No pharmacologic dilation; 45-degree field of view; color fundus image:
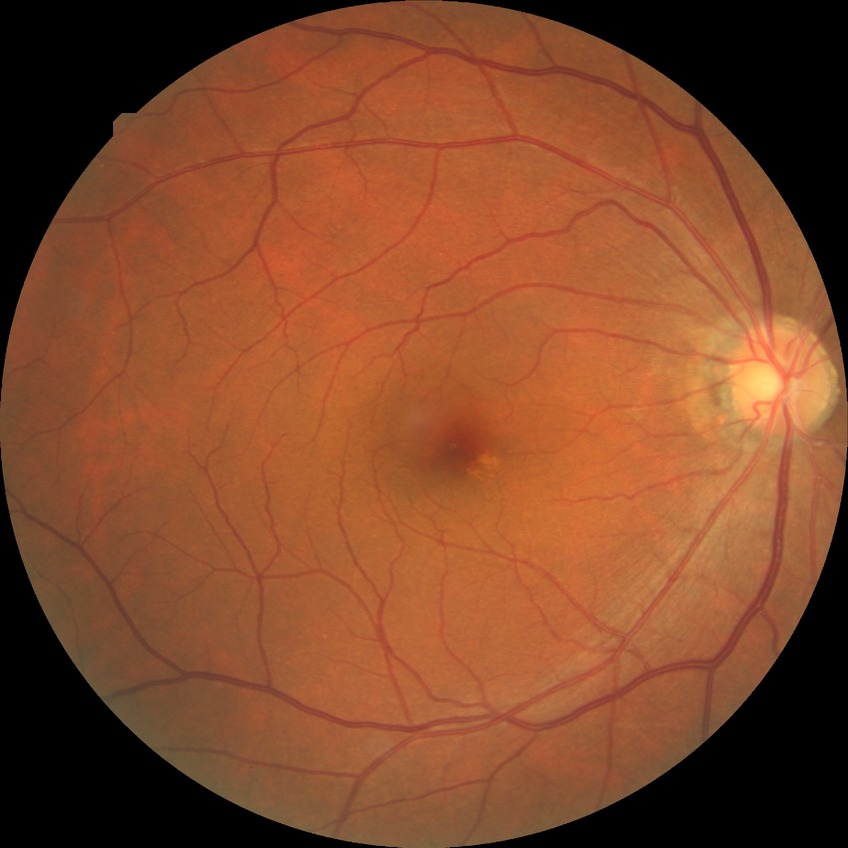

– diabetic retinopathy (DR) — NDR (no diabetic retinopathy)